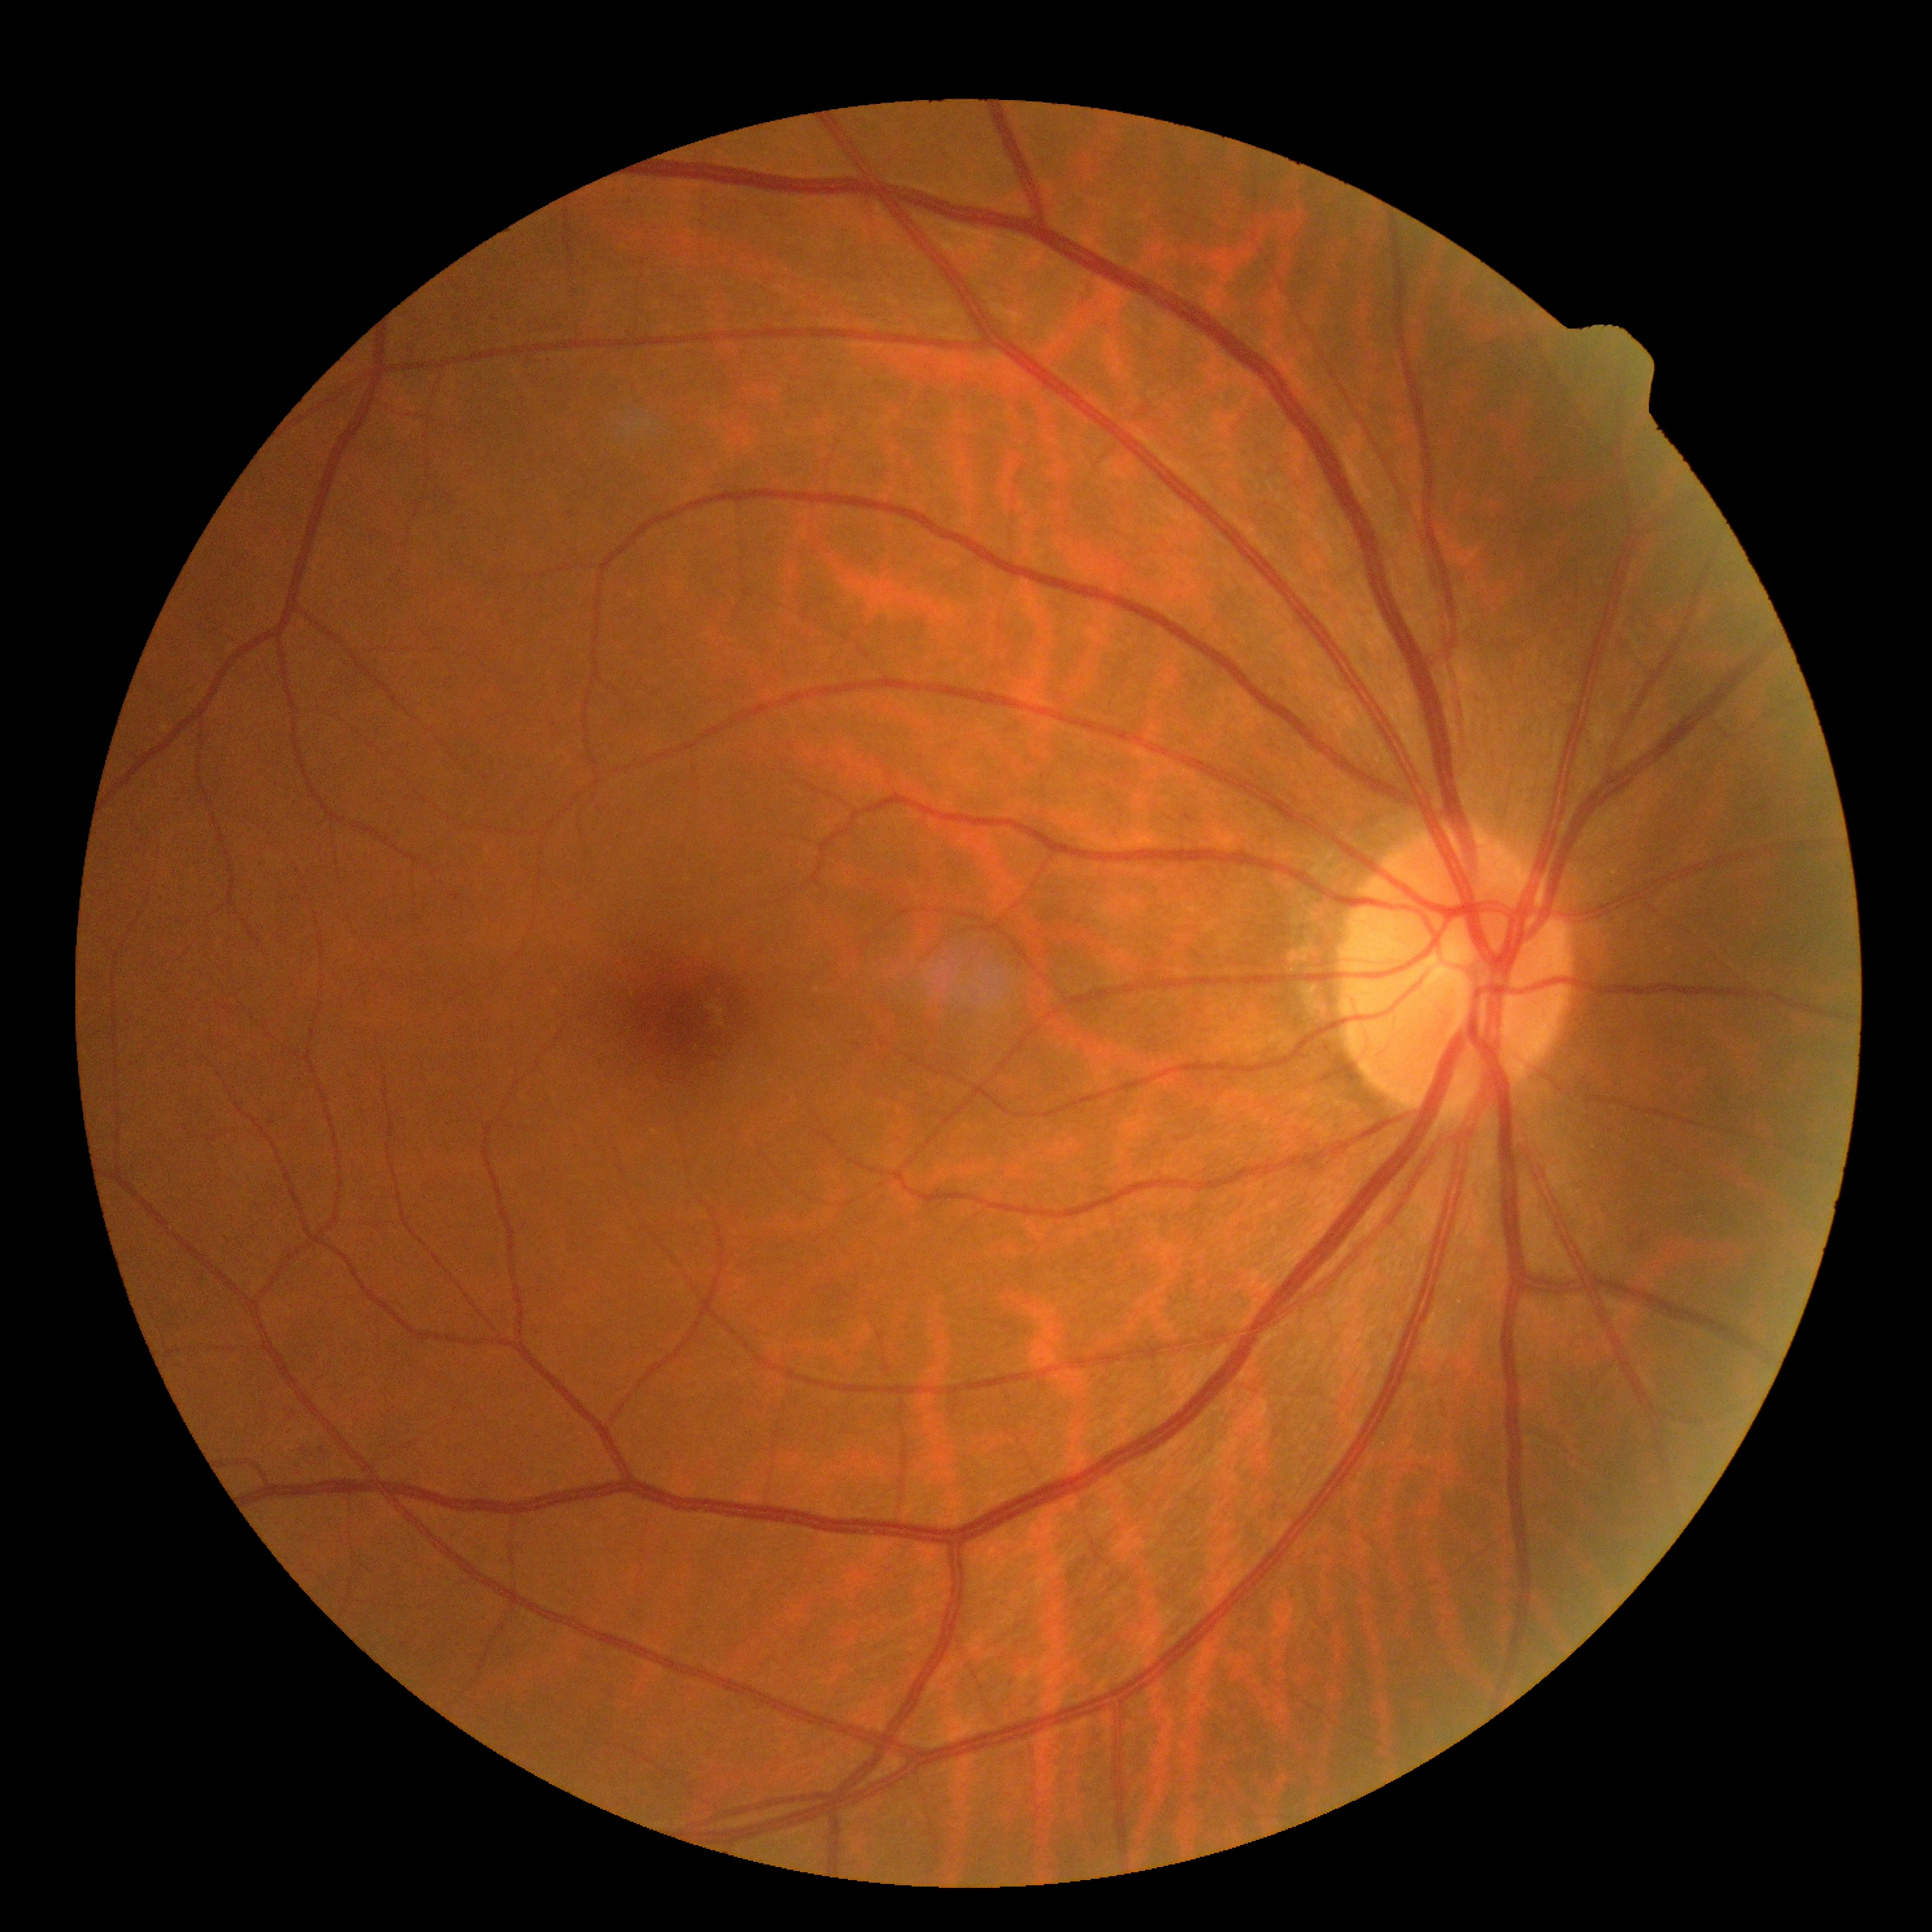
DR class: non-proliferative diabetic retinopathy; diabetic retinopathy severity: 2/4.